Camera: NIDEK AFC-230
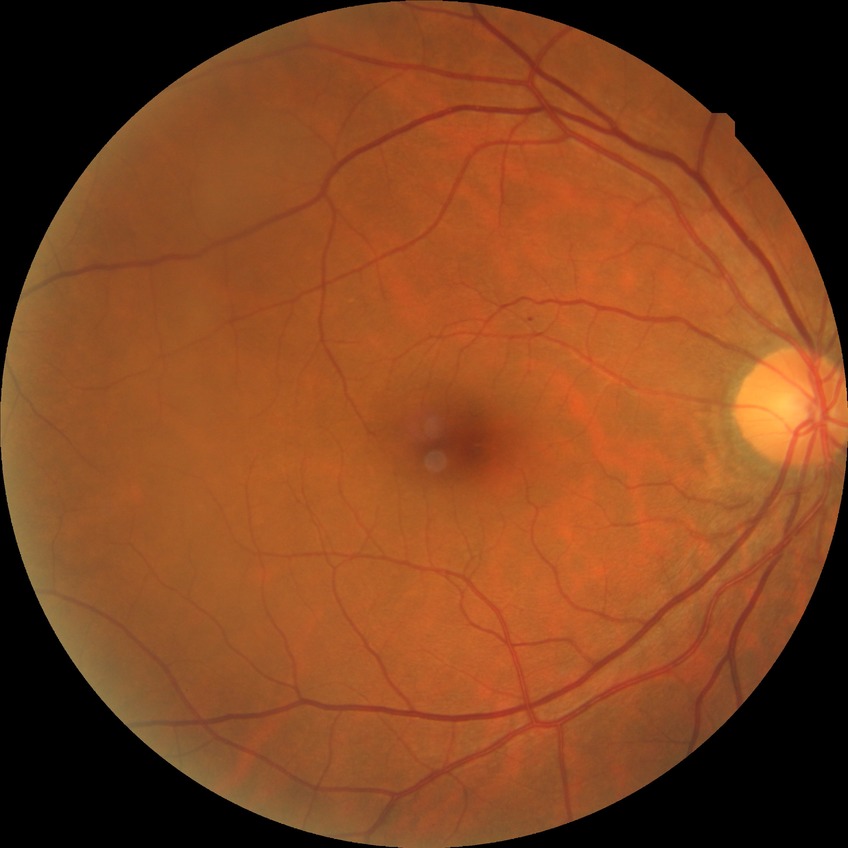
Diabetic retinopathy (DR): NDR (no diabetic retinopathy).